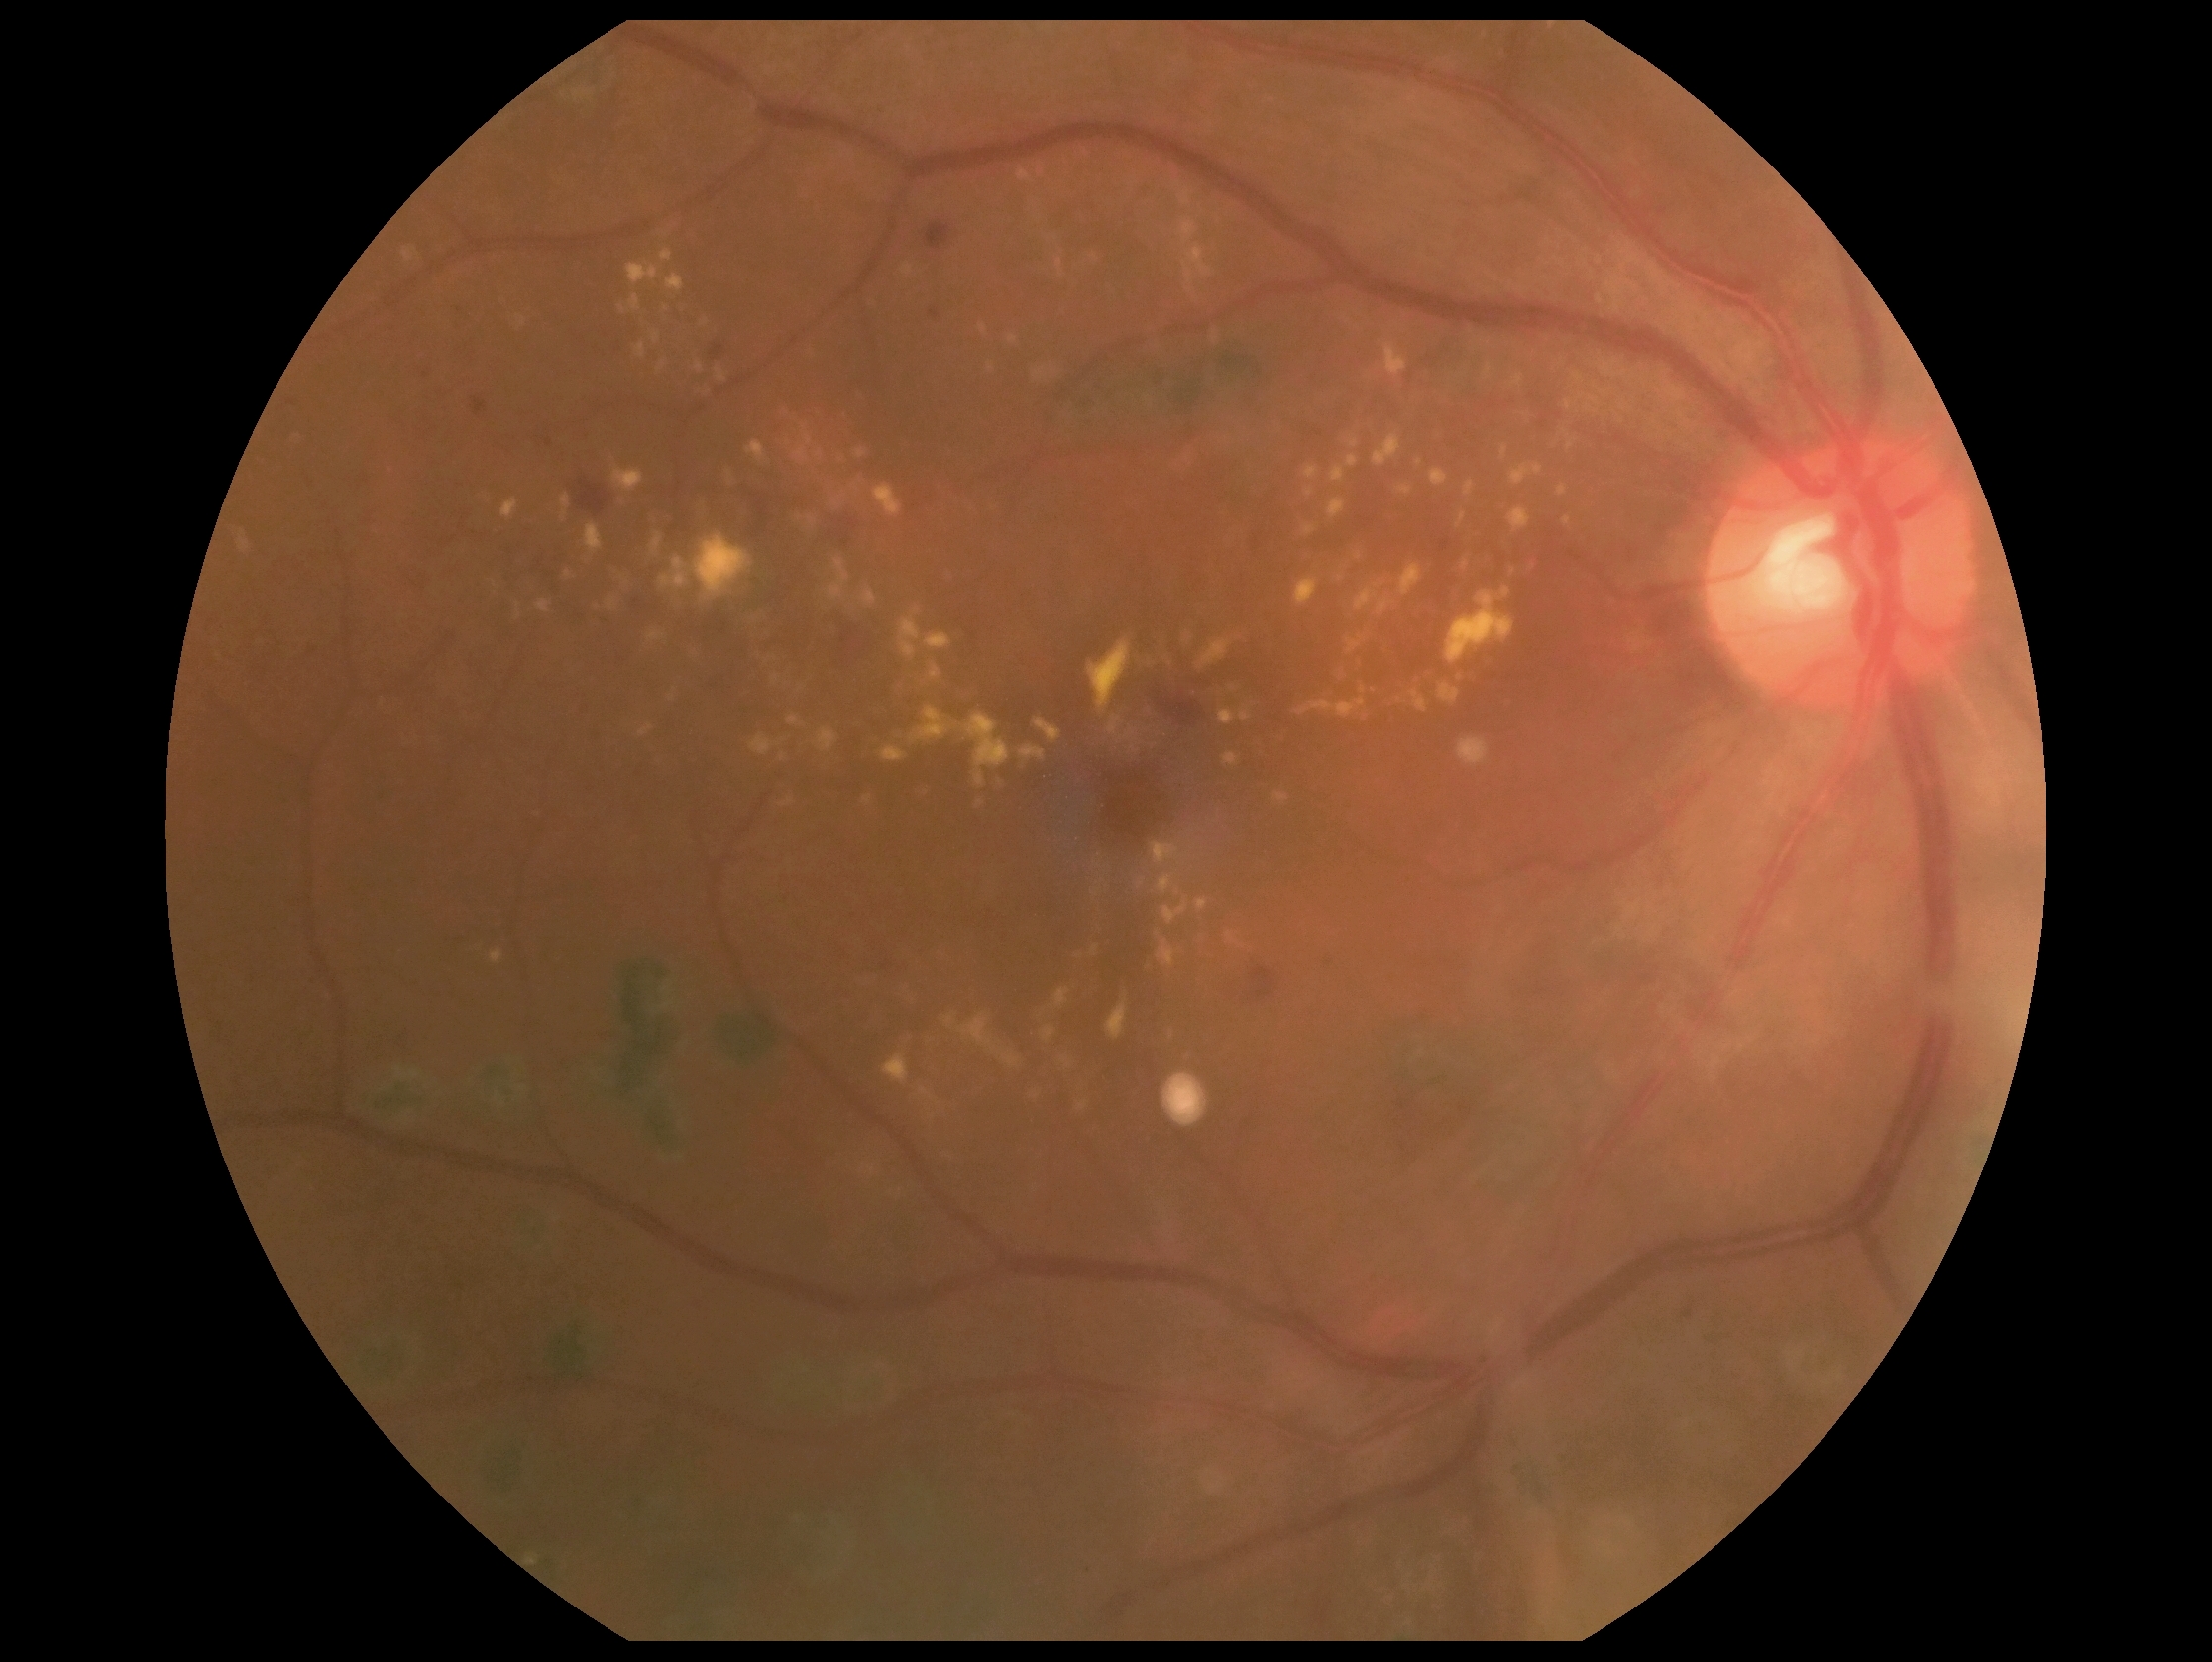

DR: 2.